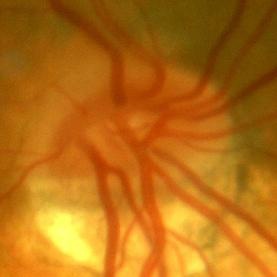

Glaucoma assessment = no glaucomatous findings.